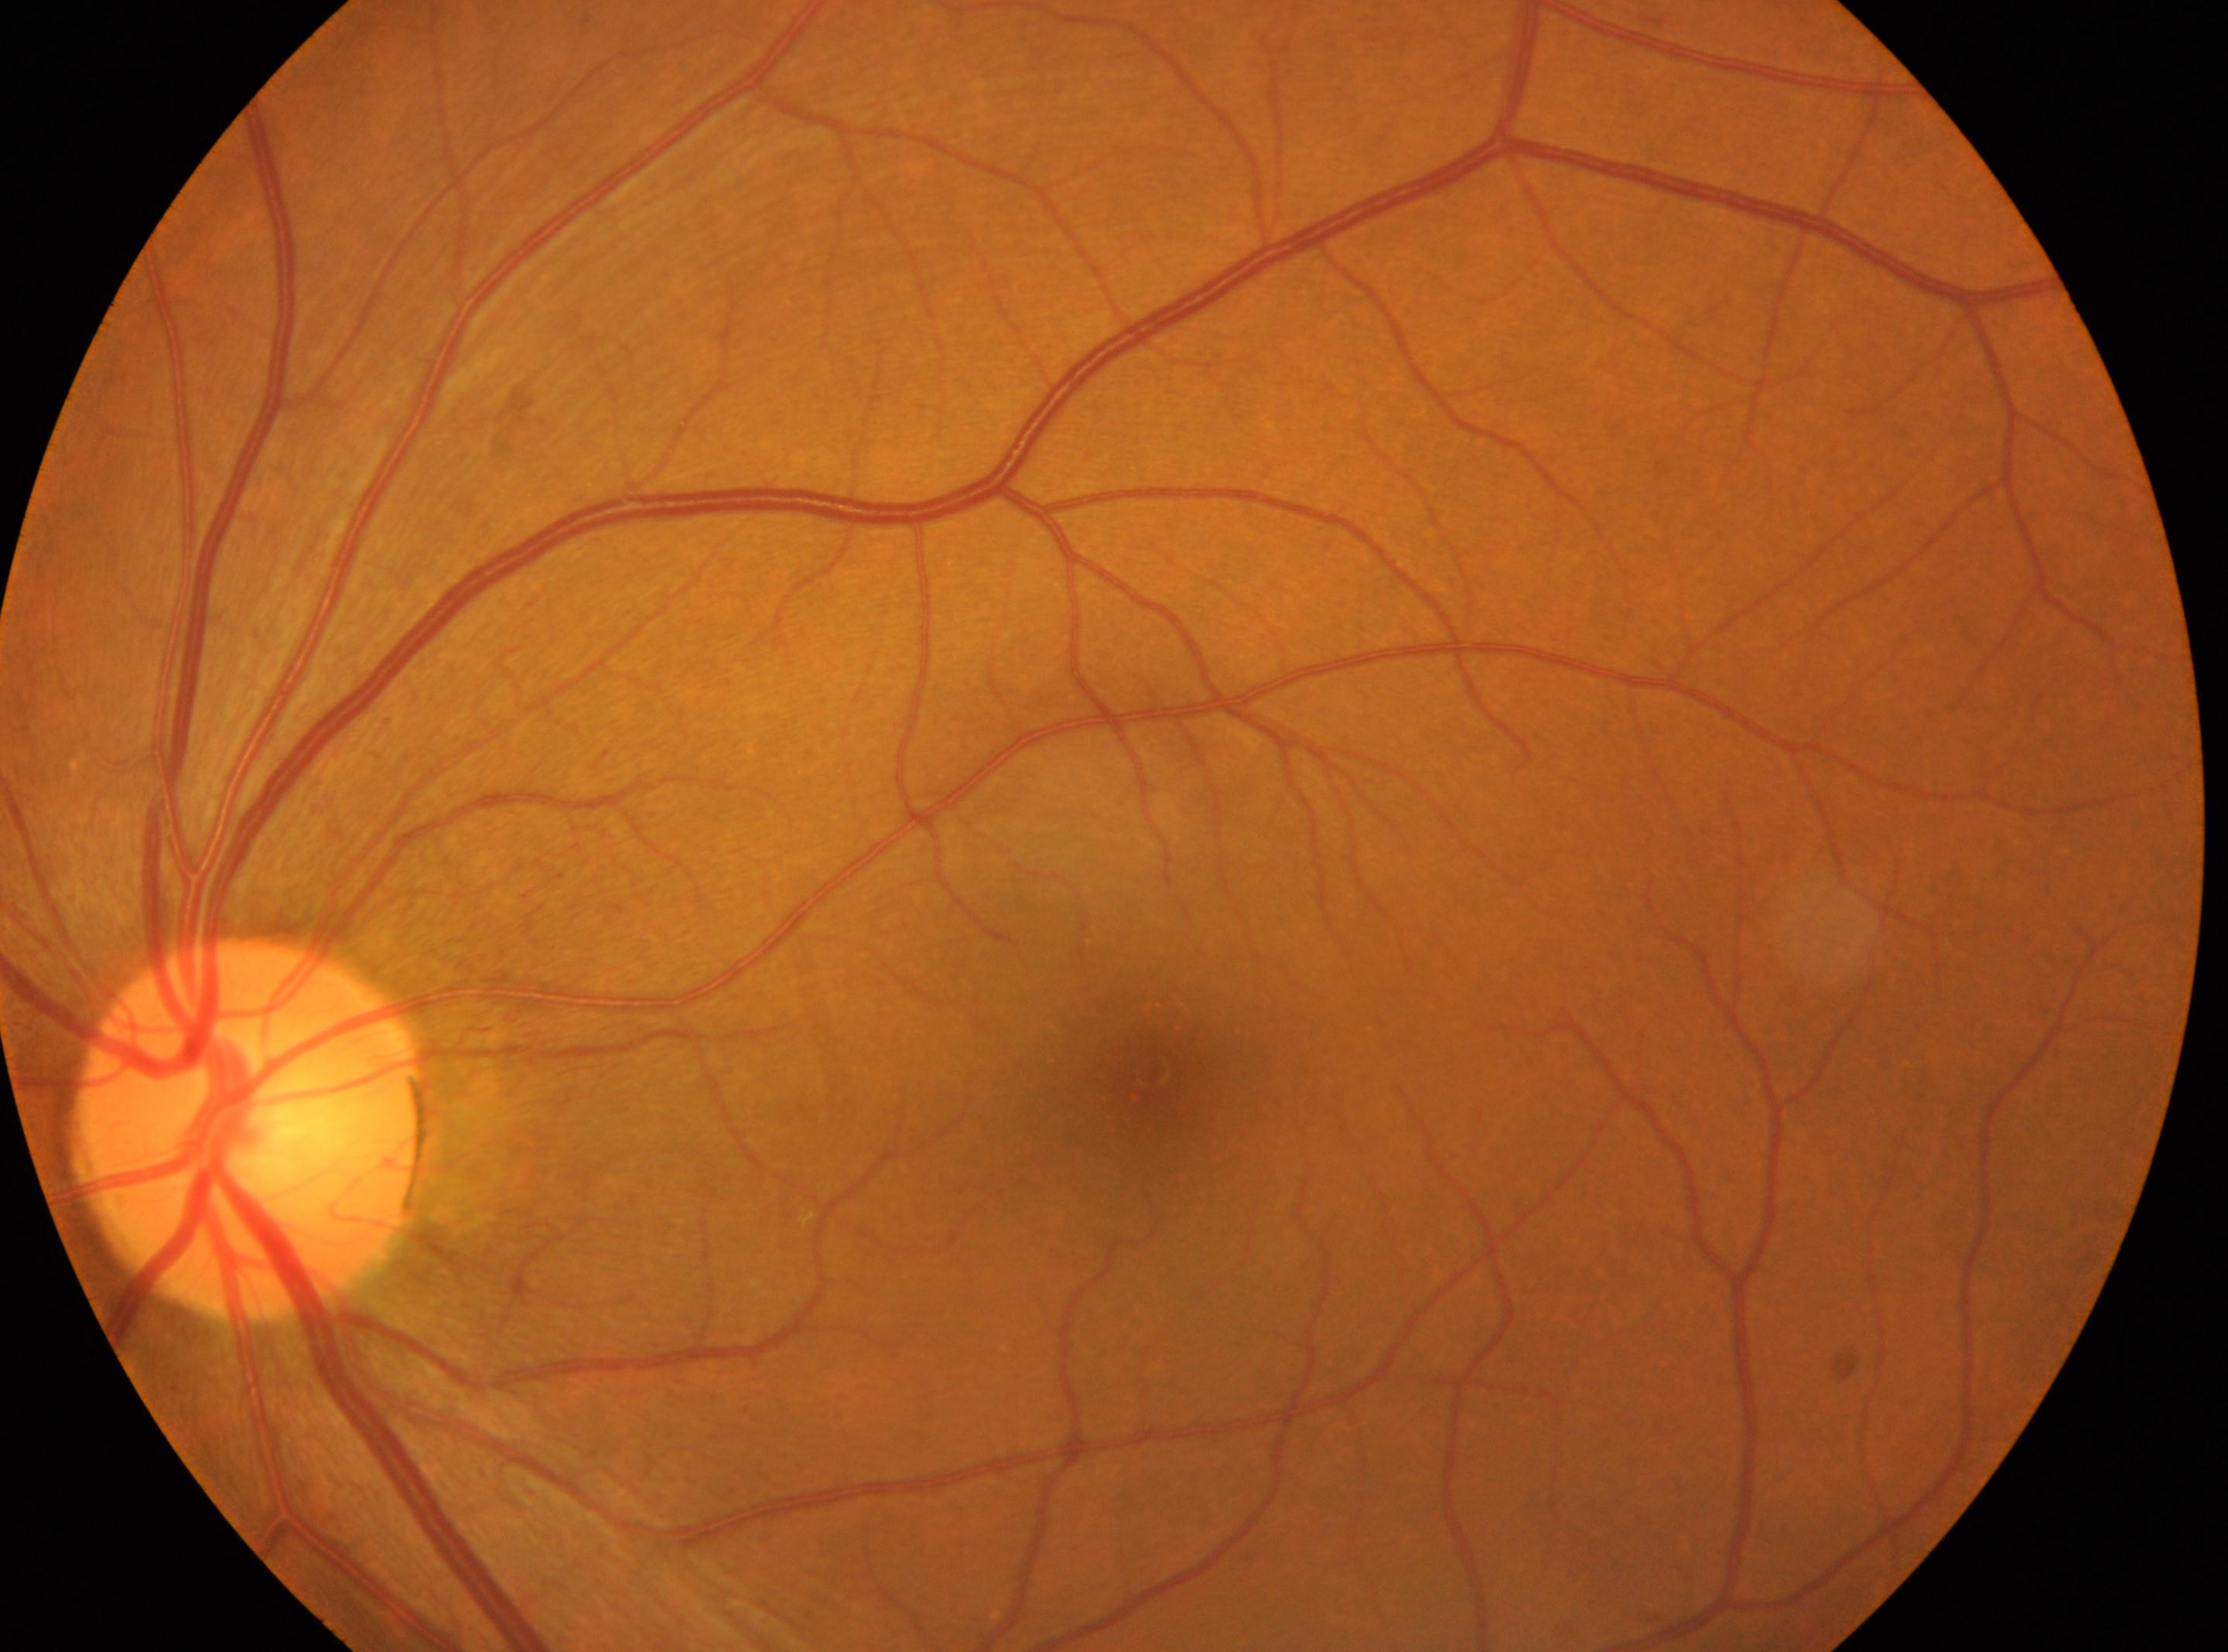
Diabetic retinopathy (DR) is grade 0 (no apparent retinopathy).
This is the OS.
Optic disc located at (248, 1128).
Macular center located at (1151, 1070).